45° field of view; 848 x 848 pixels; nonmydriatic fundus photograph.
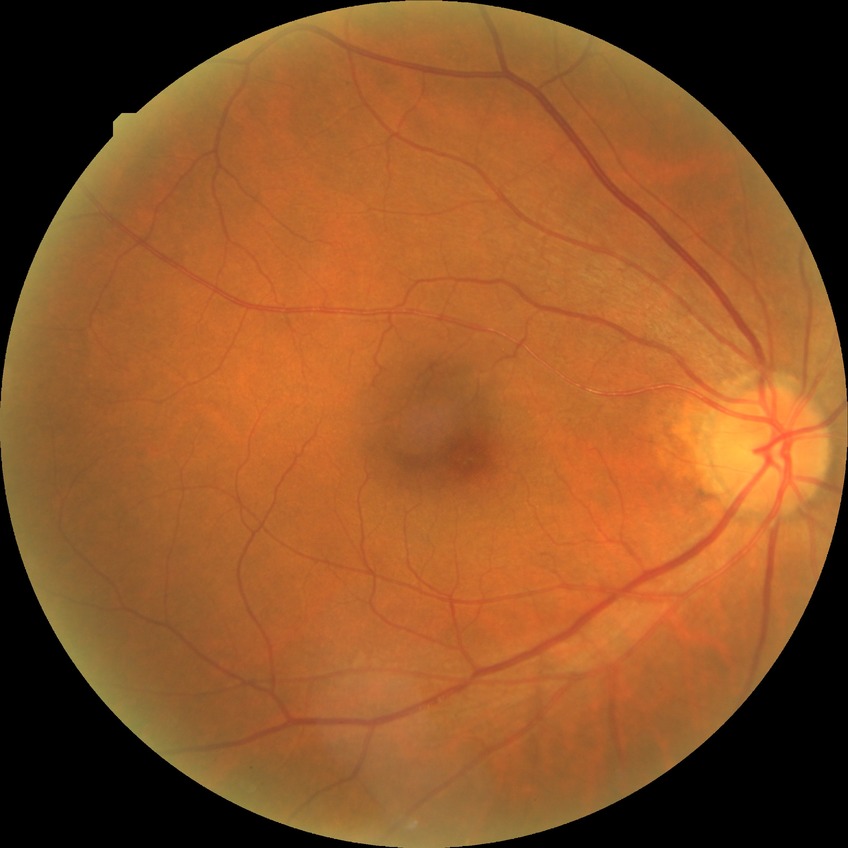 Diabetic retinopathy severity: simple diabetic retinopathy.